Posterior pole photograph, 848x848px, 45 degree fundus photograph, nonmydriatic — 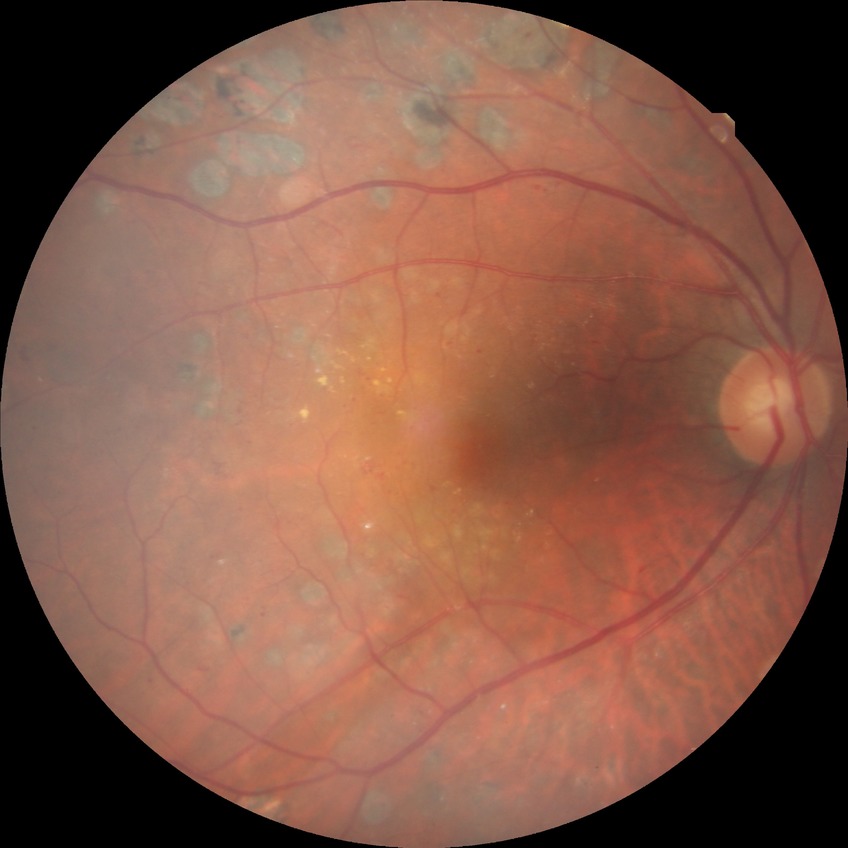 Diabetic retinopathy (DR) is proliferative diabetic retinopathy (PDR).